45° field of view.
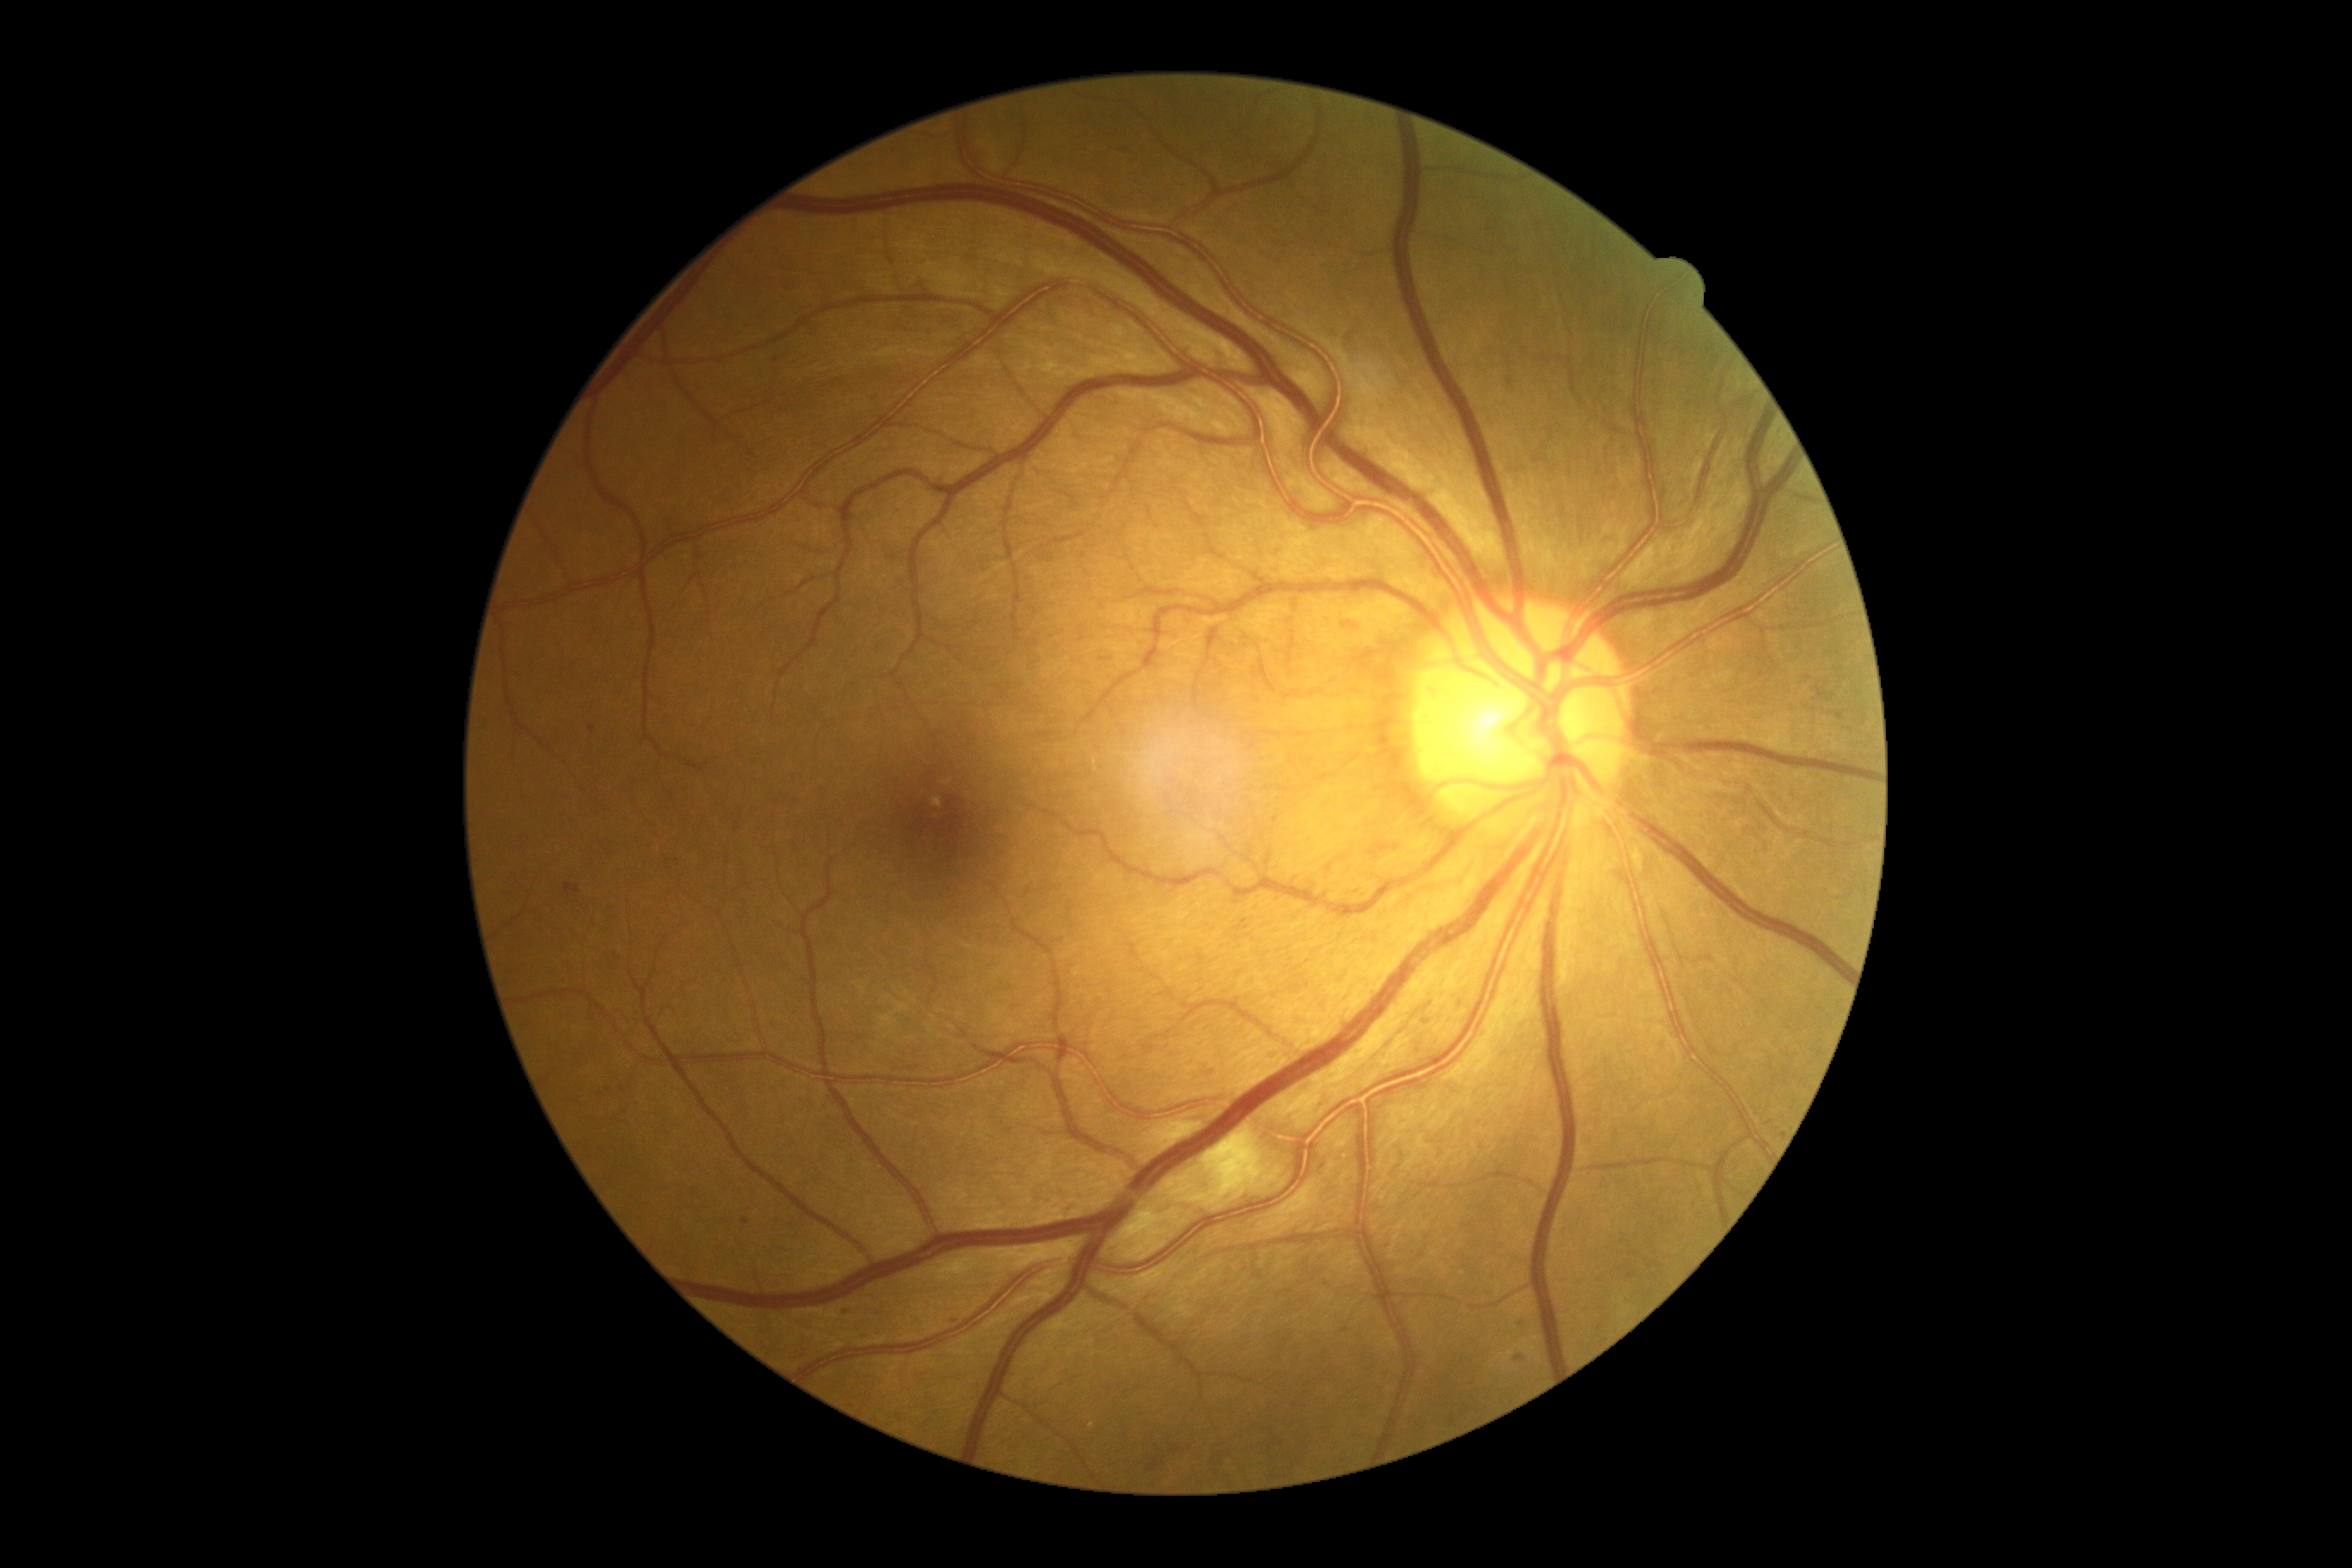

Retinopathy grade: 2 (moderate NPDR) — more than just microaneurysms but less than severe NPDR.